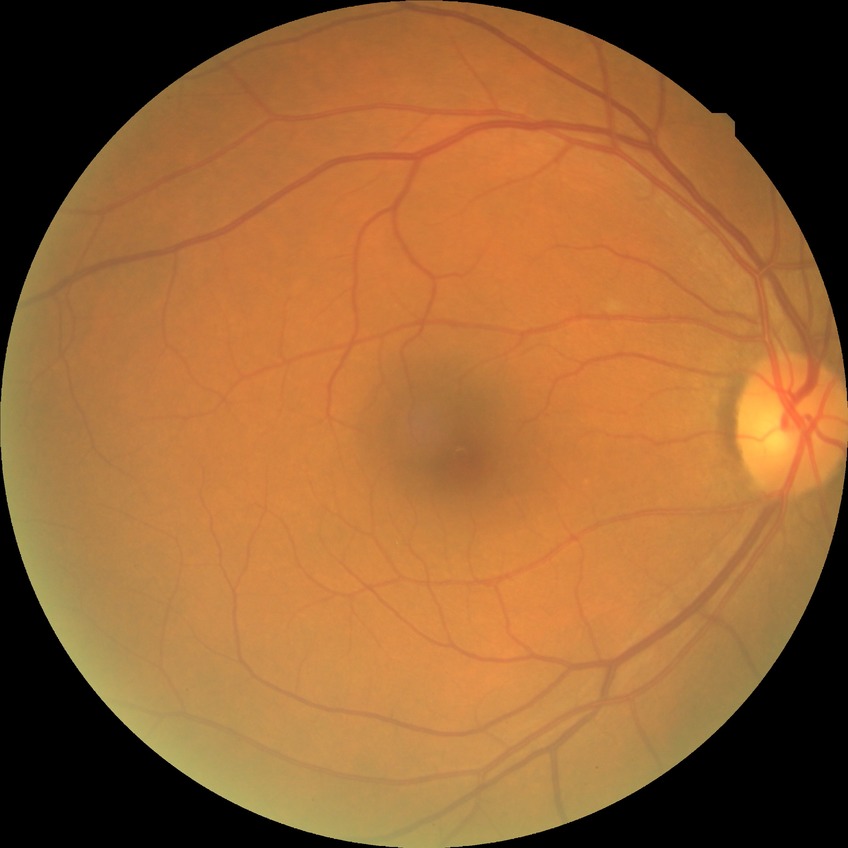 Diabetic retinopathy (DR): NDR (no diabetic retinopathy).